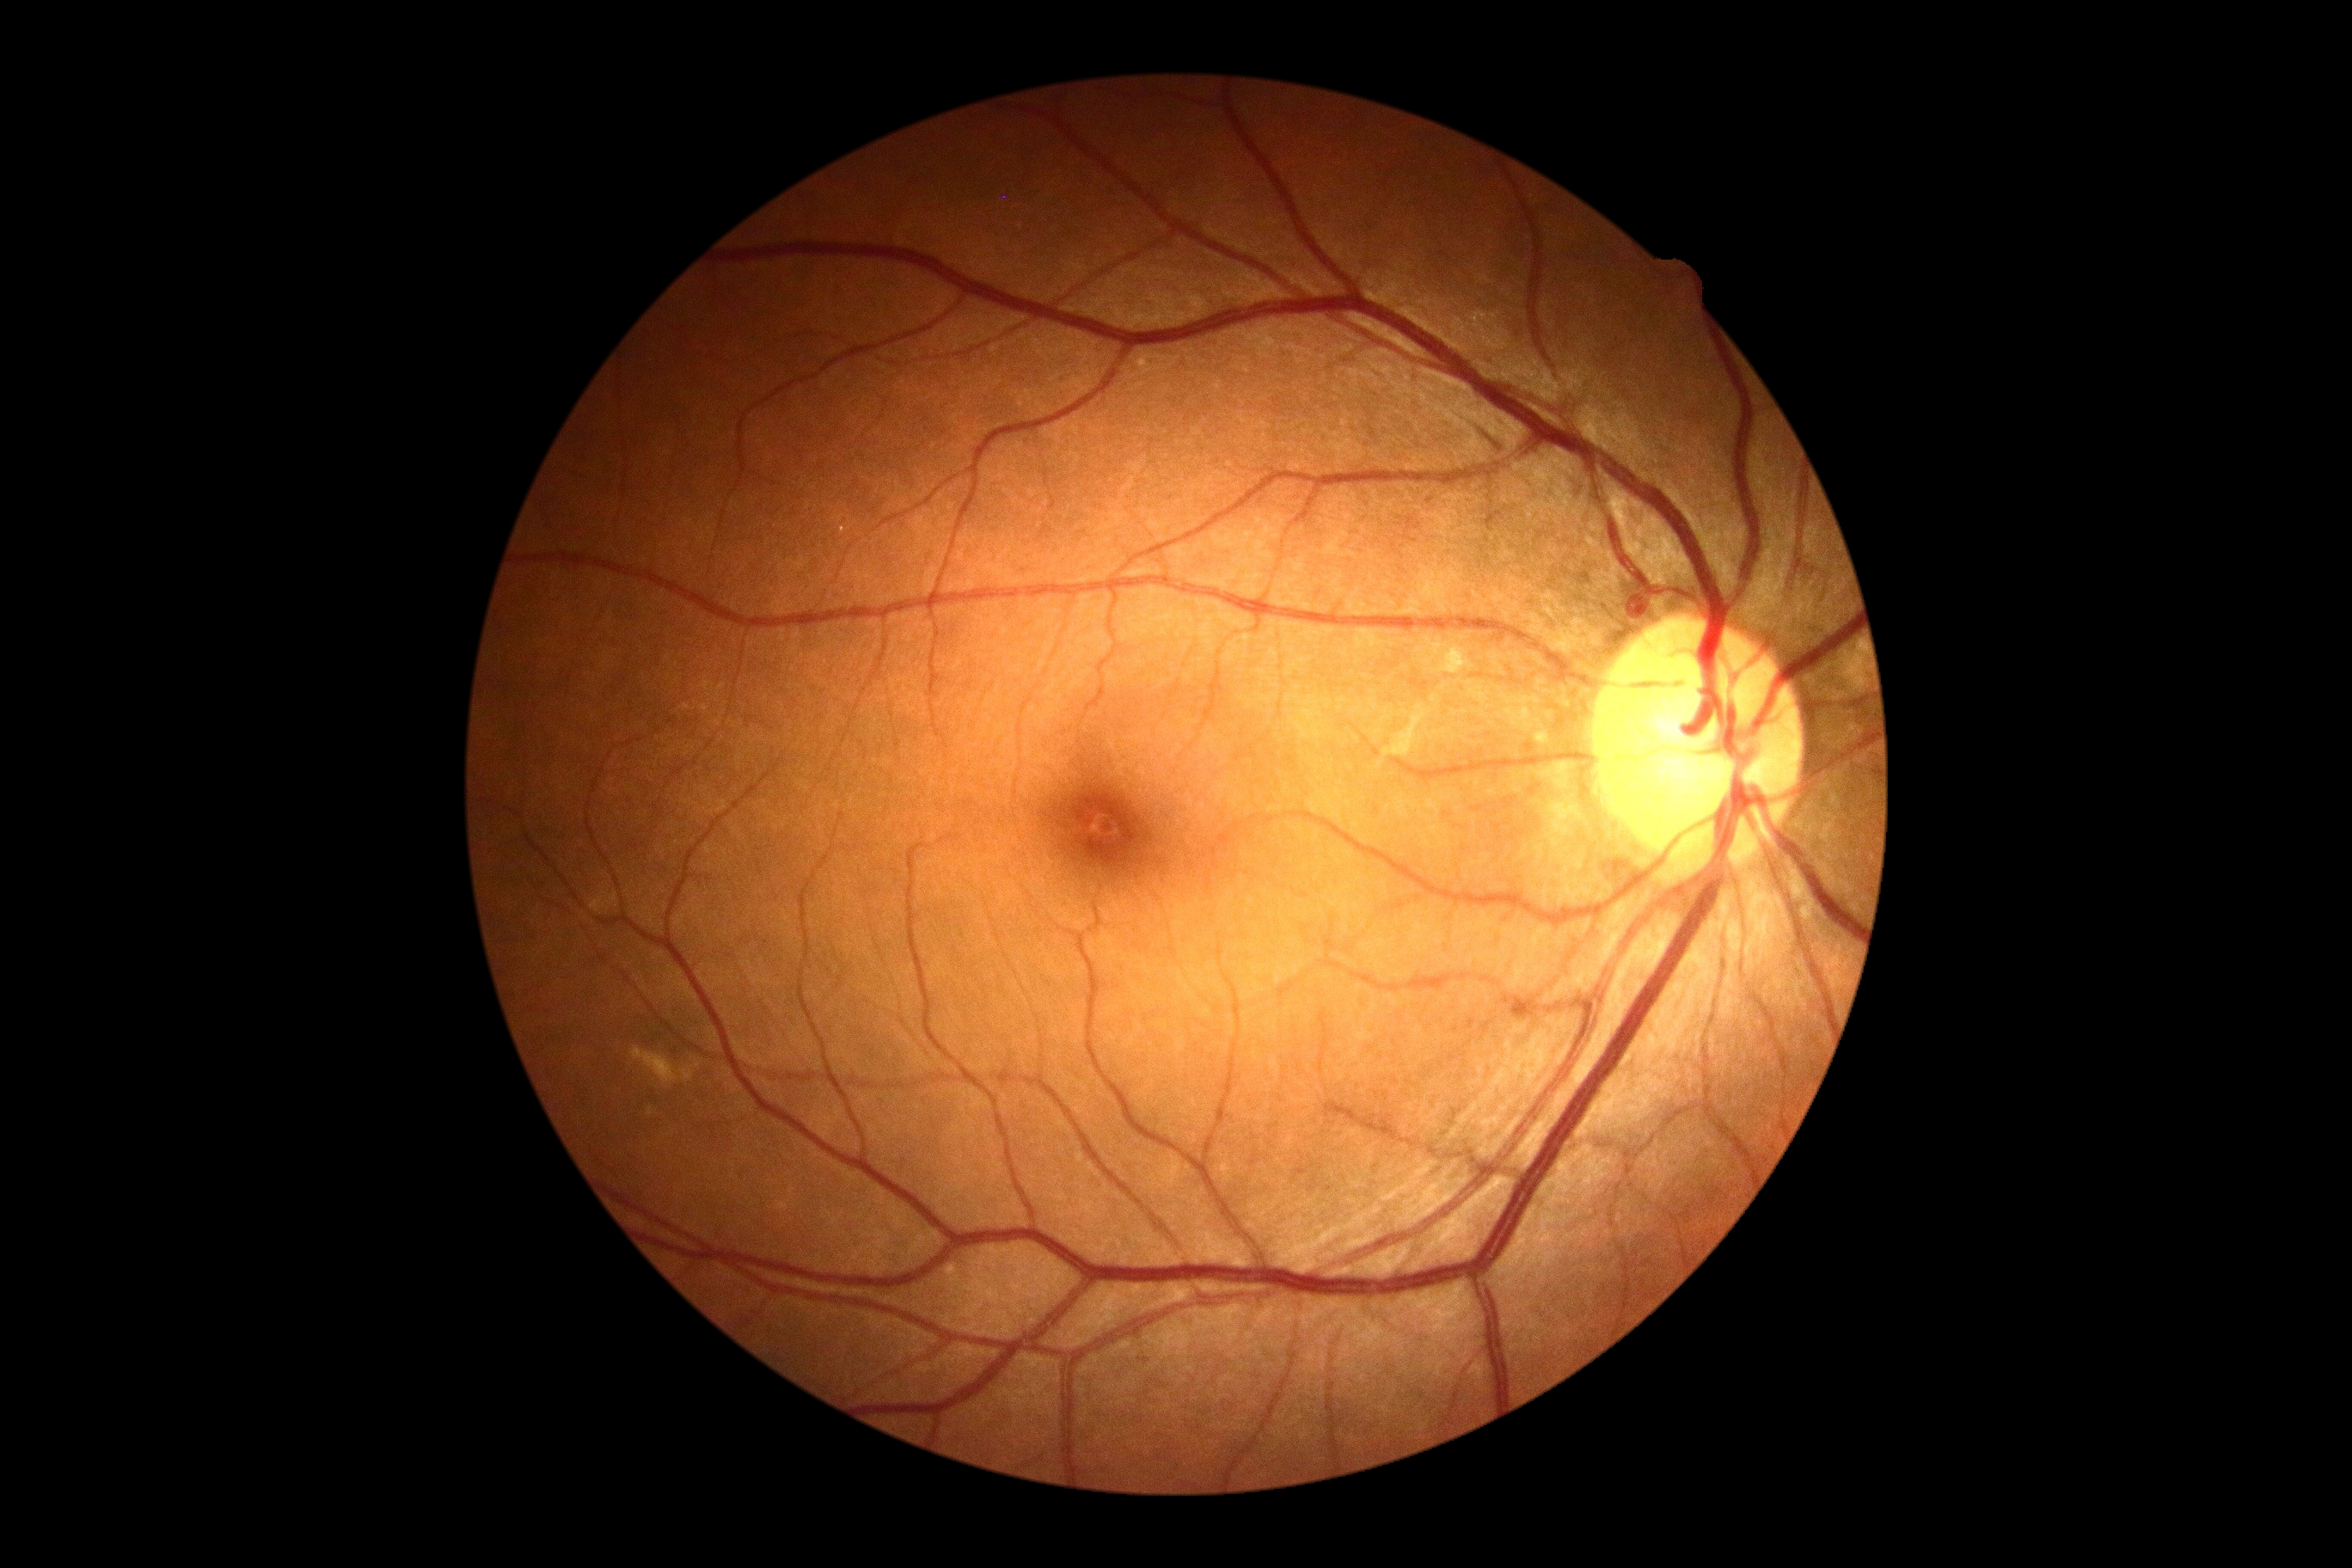

Diabetic retinopathy severity: no apparent retinopathy (grade 0).